848 by 848 pixels. No pharmacologic dilation — 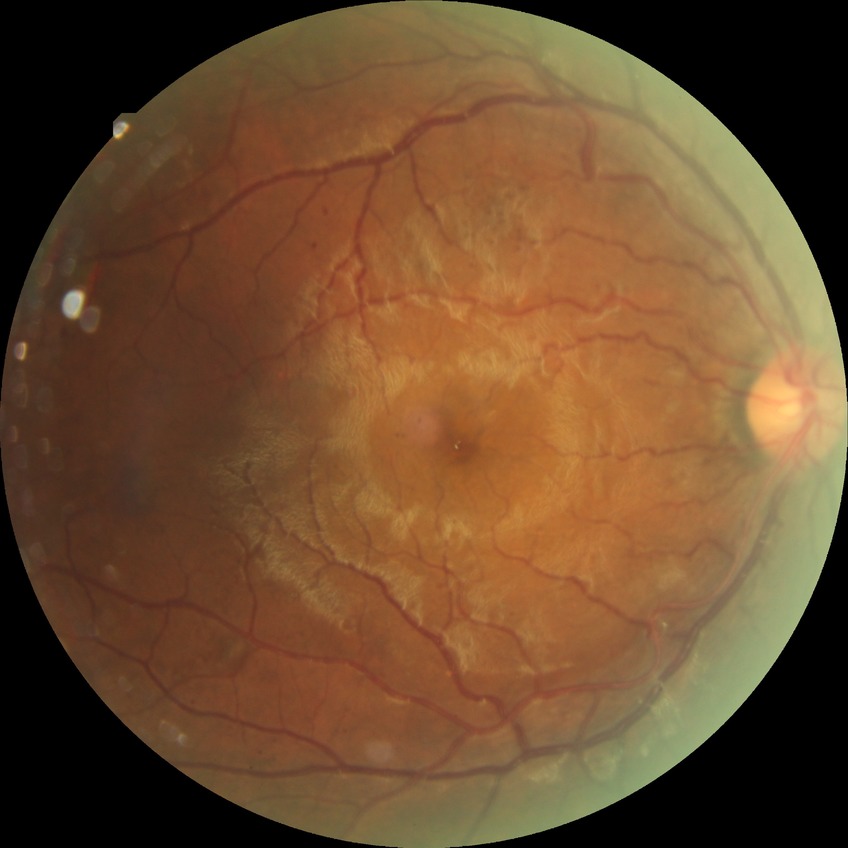
Diabetic retinopathy (DR) is pre-proliferative diabetic retinopathy (PPDR).